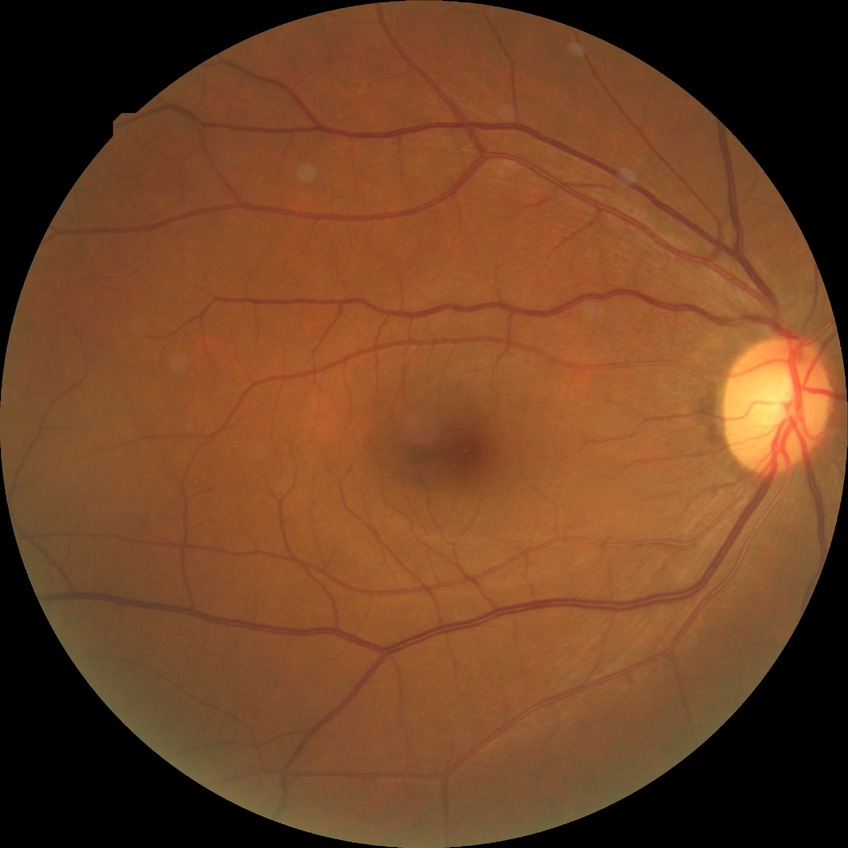
diabetic retinopathy (DR) = NDR (no diabetic retinopathy).